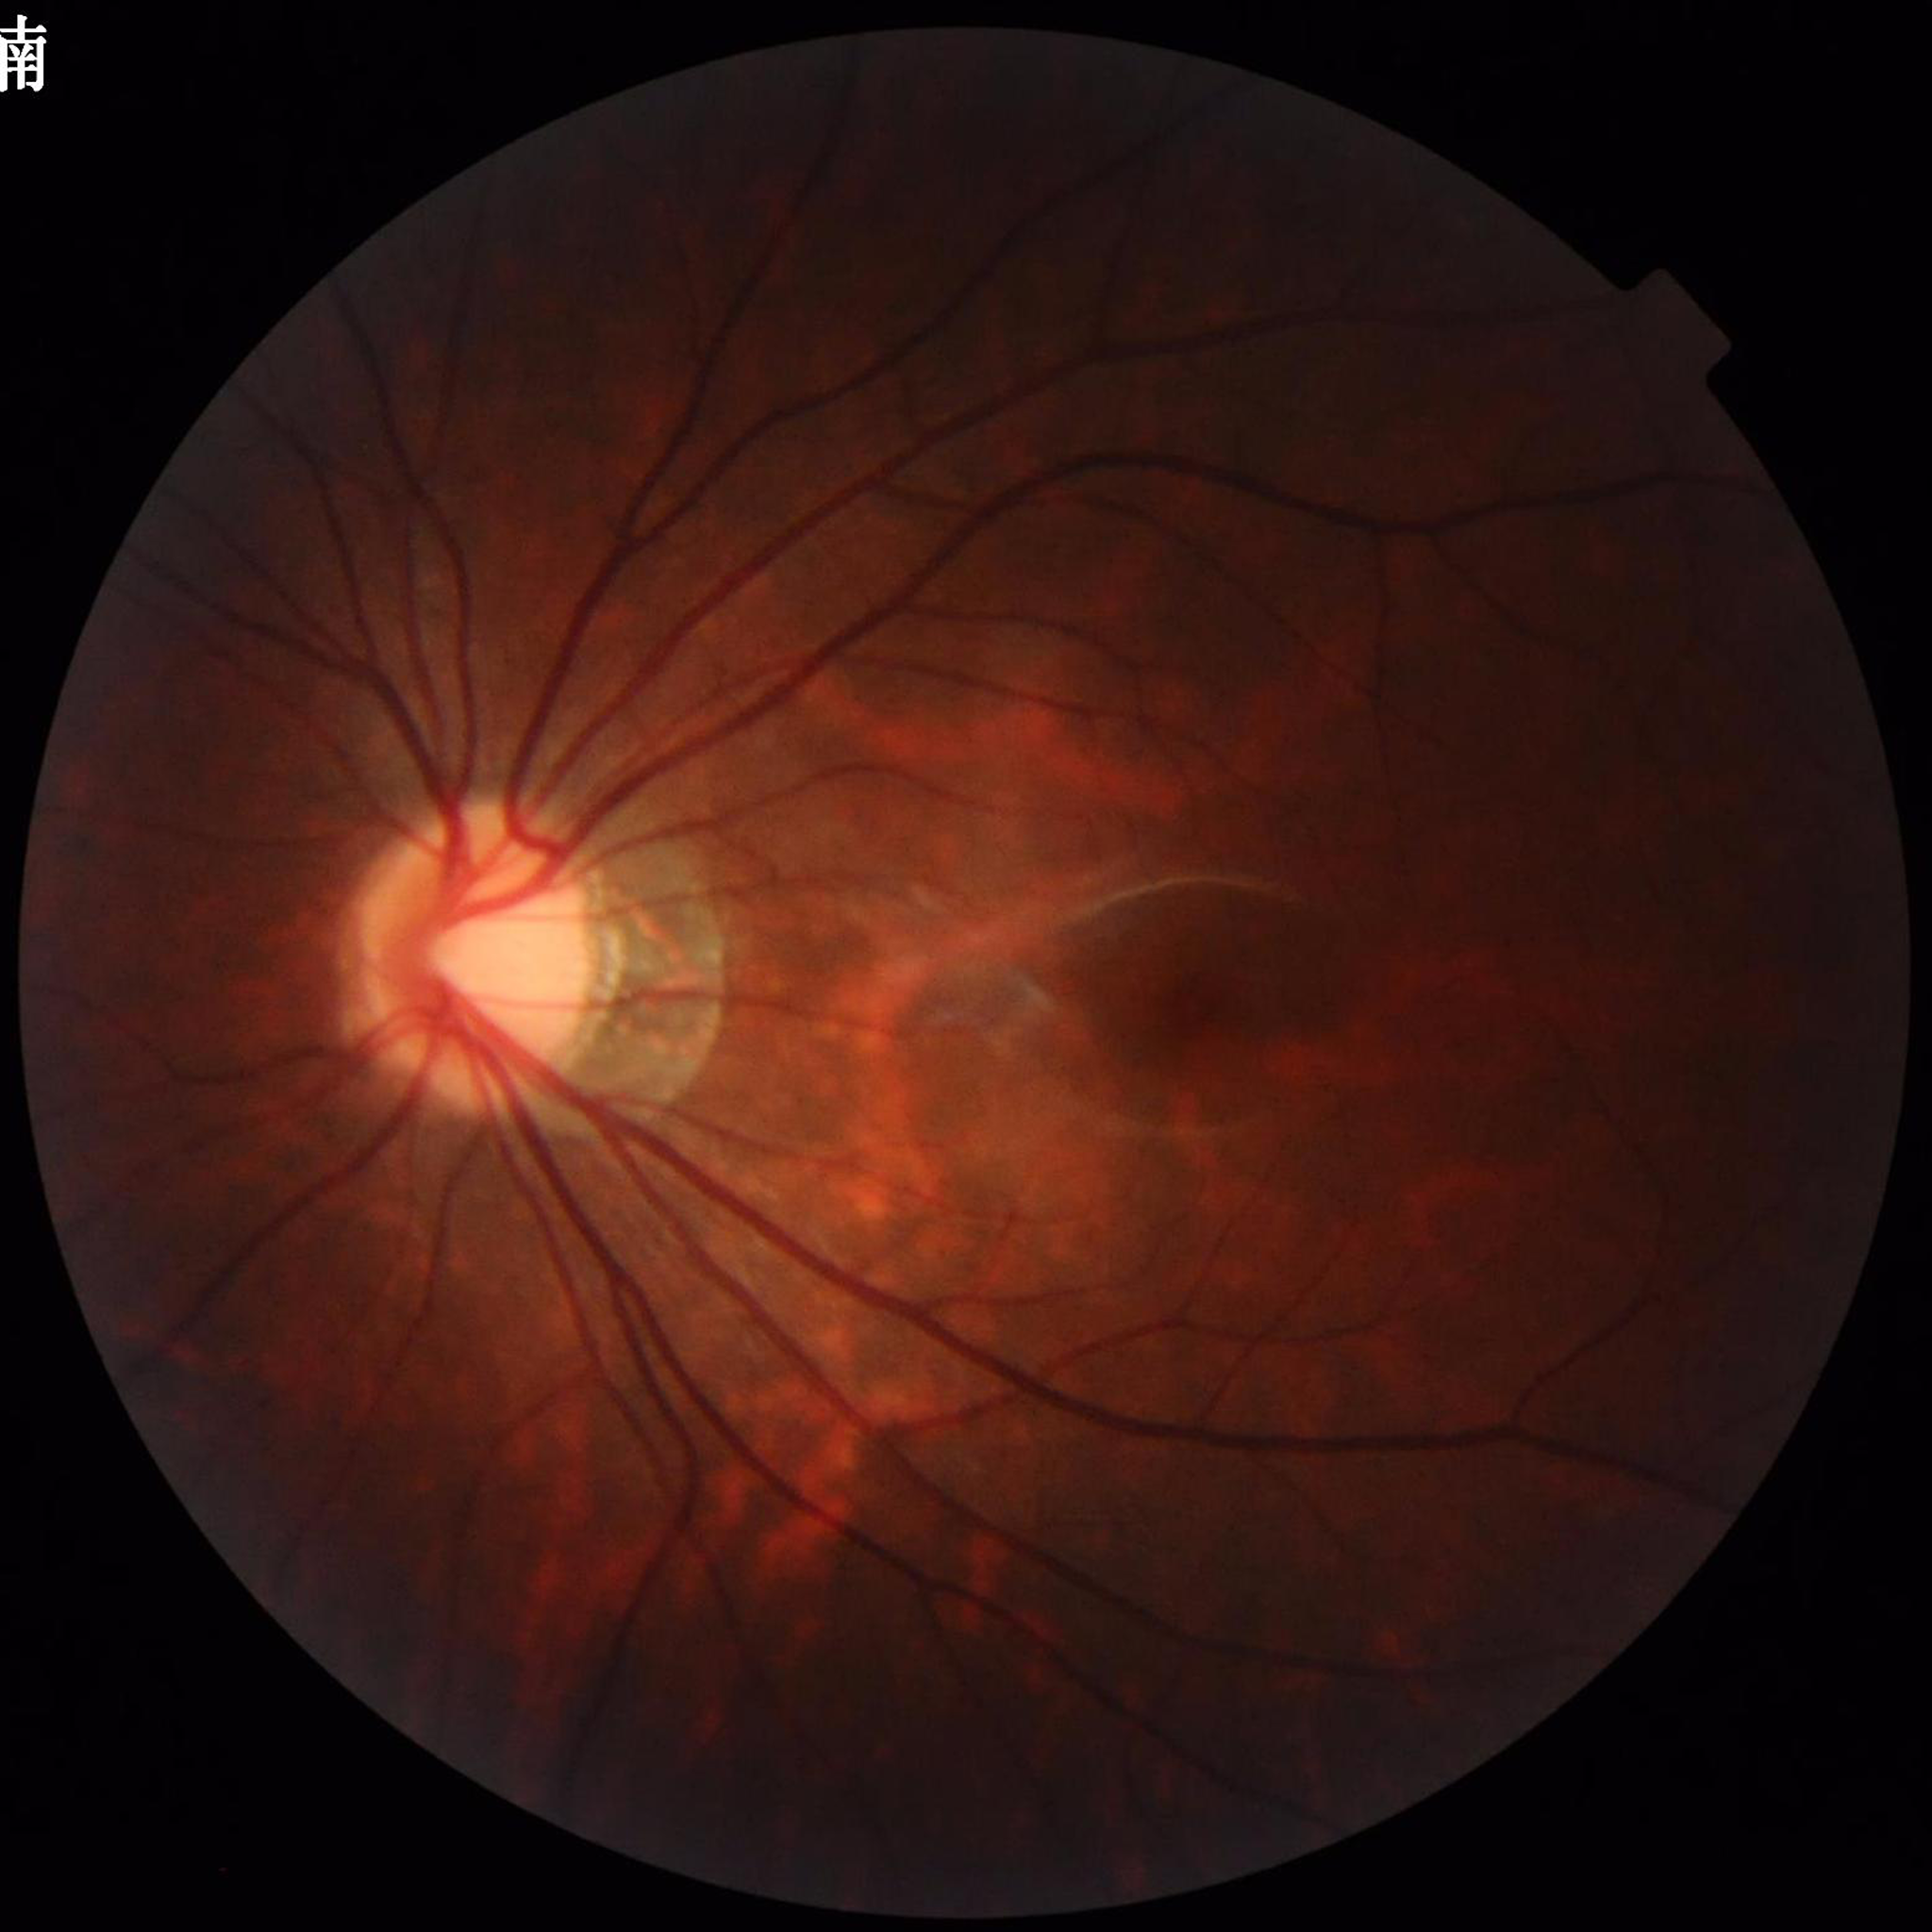

Fundus image of an eye with glaucoma.